Modified Davis classification:
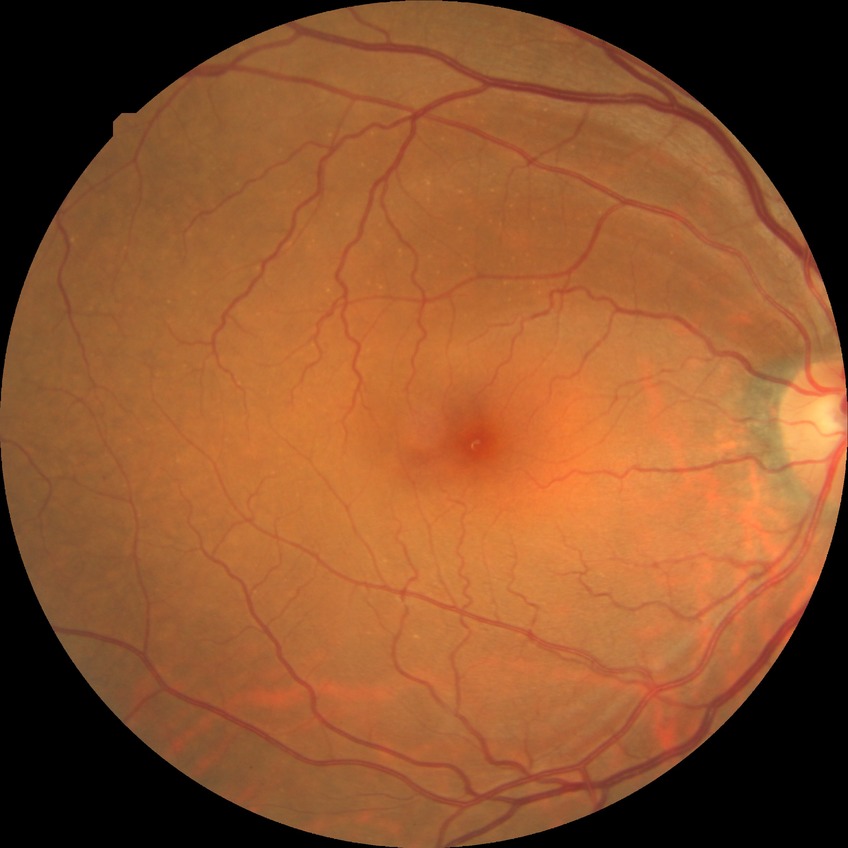 Davis stage=NDR.